Color fundus photograph, 45-degree field of view
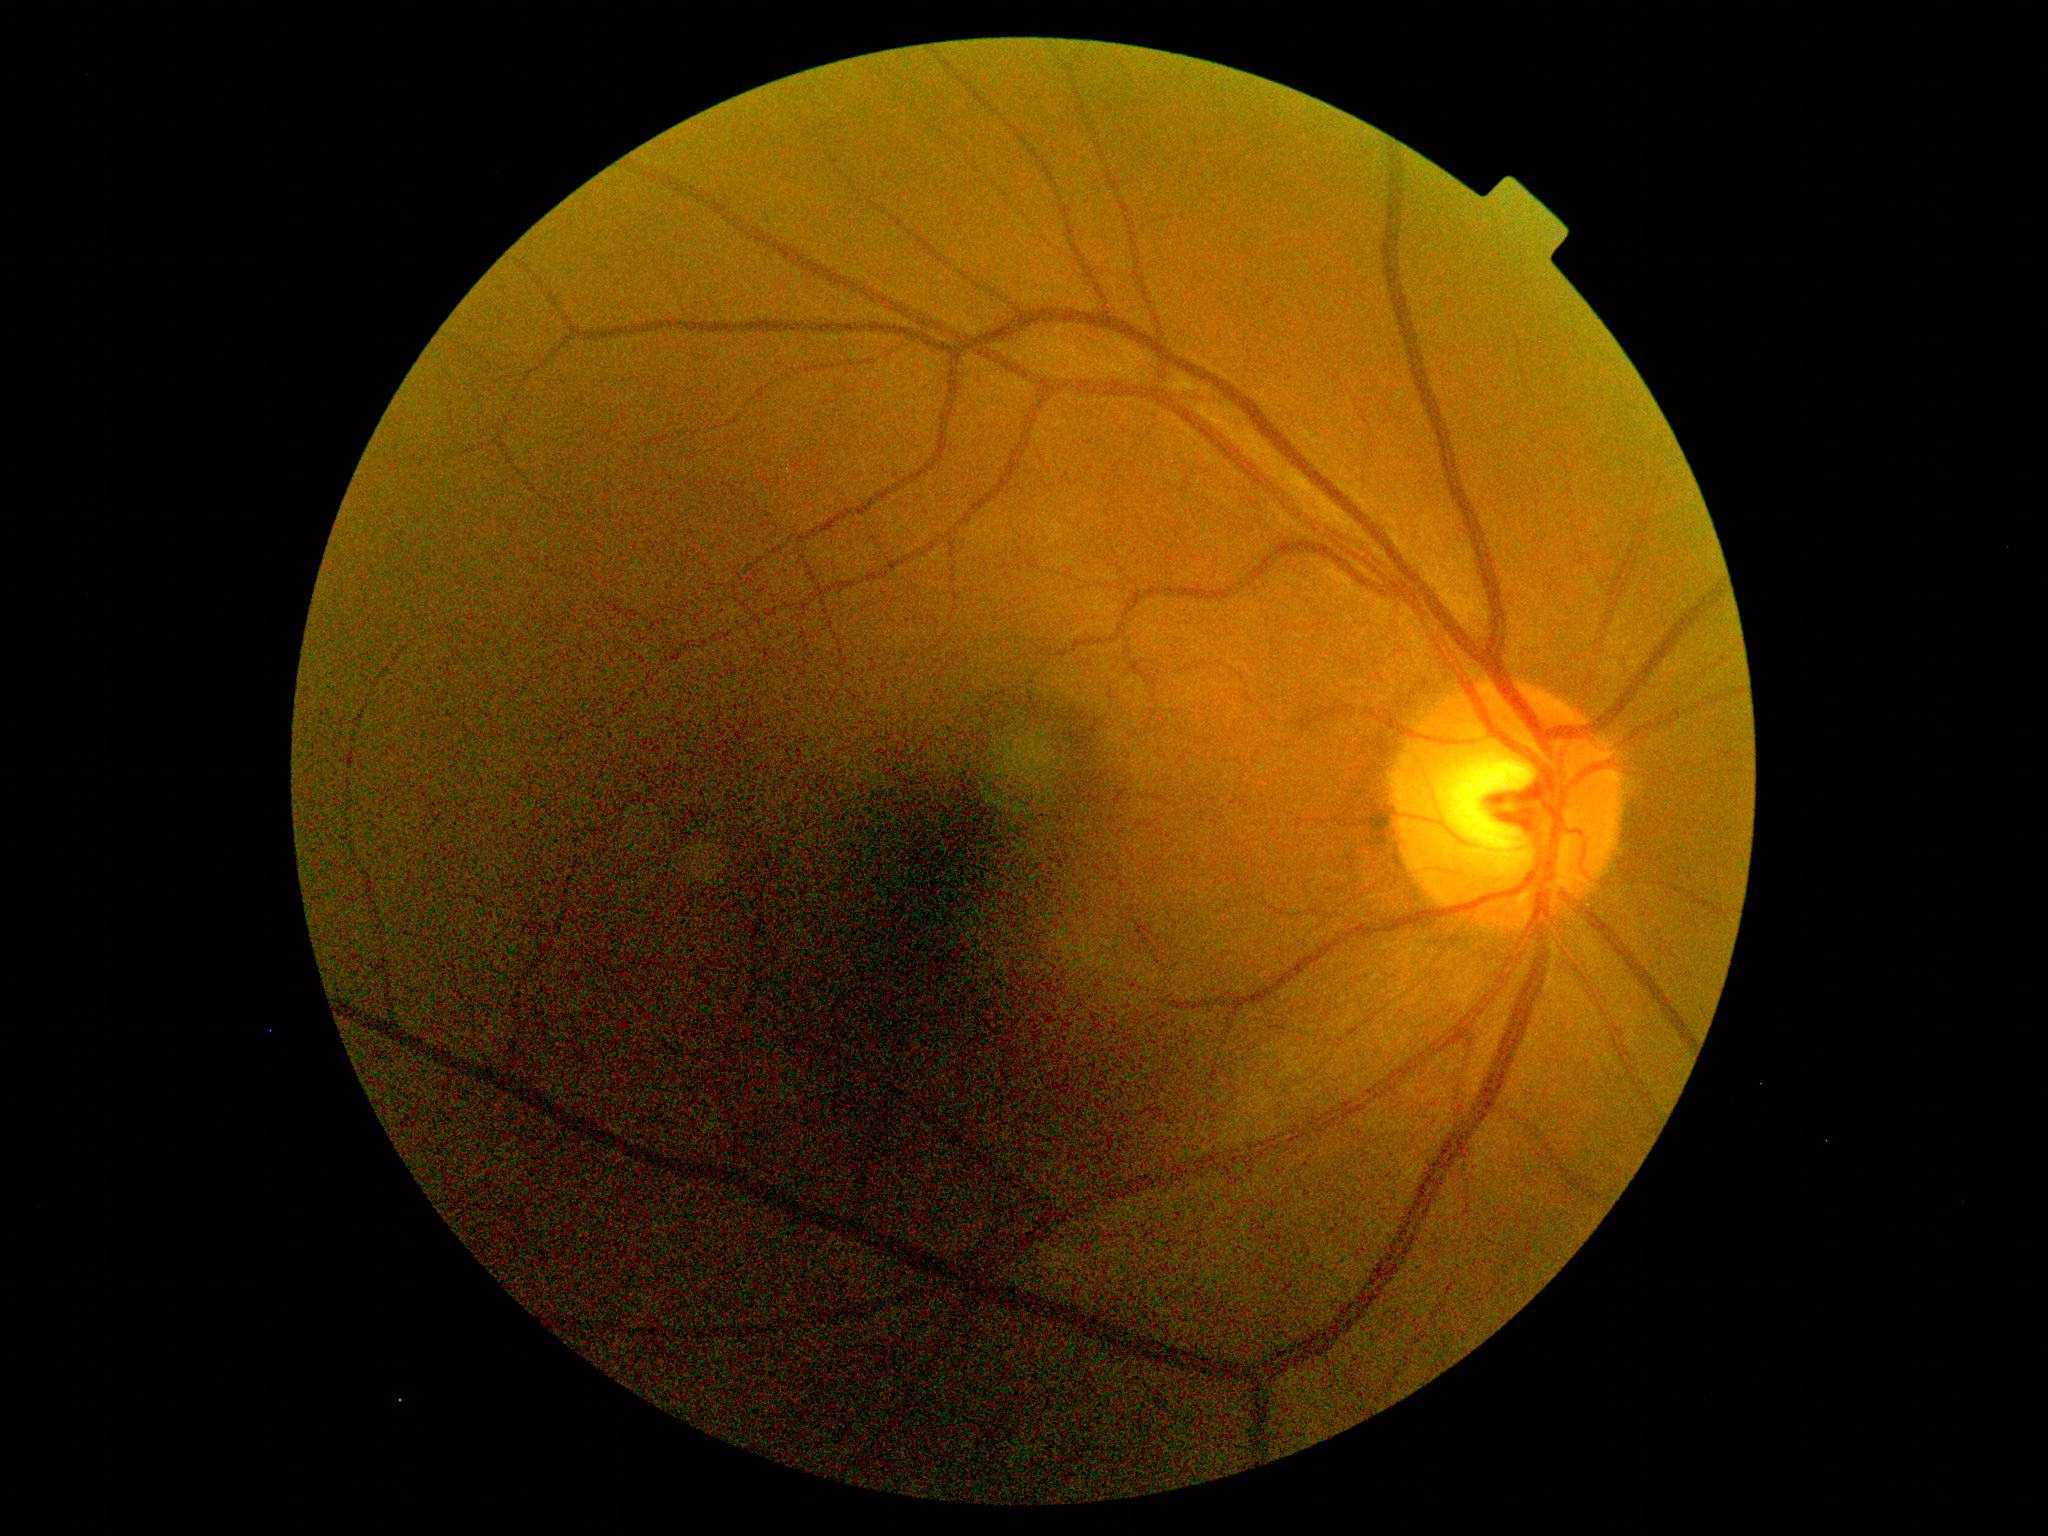
Diabetic retinopathy grade: 0 (no apparent retinopathy). No diabetic retinal disease findings.